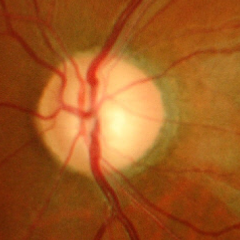

The image shows advanced glaucomatous optic neuropathy.